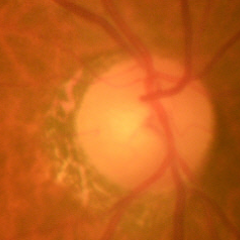 Showing no signs of glaucoma.